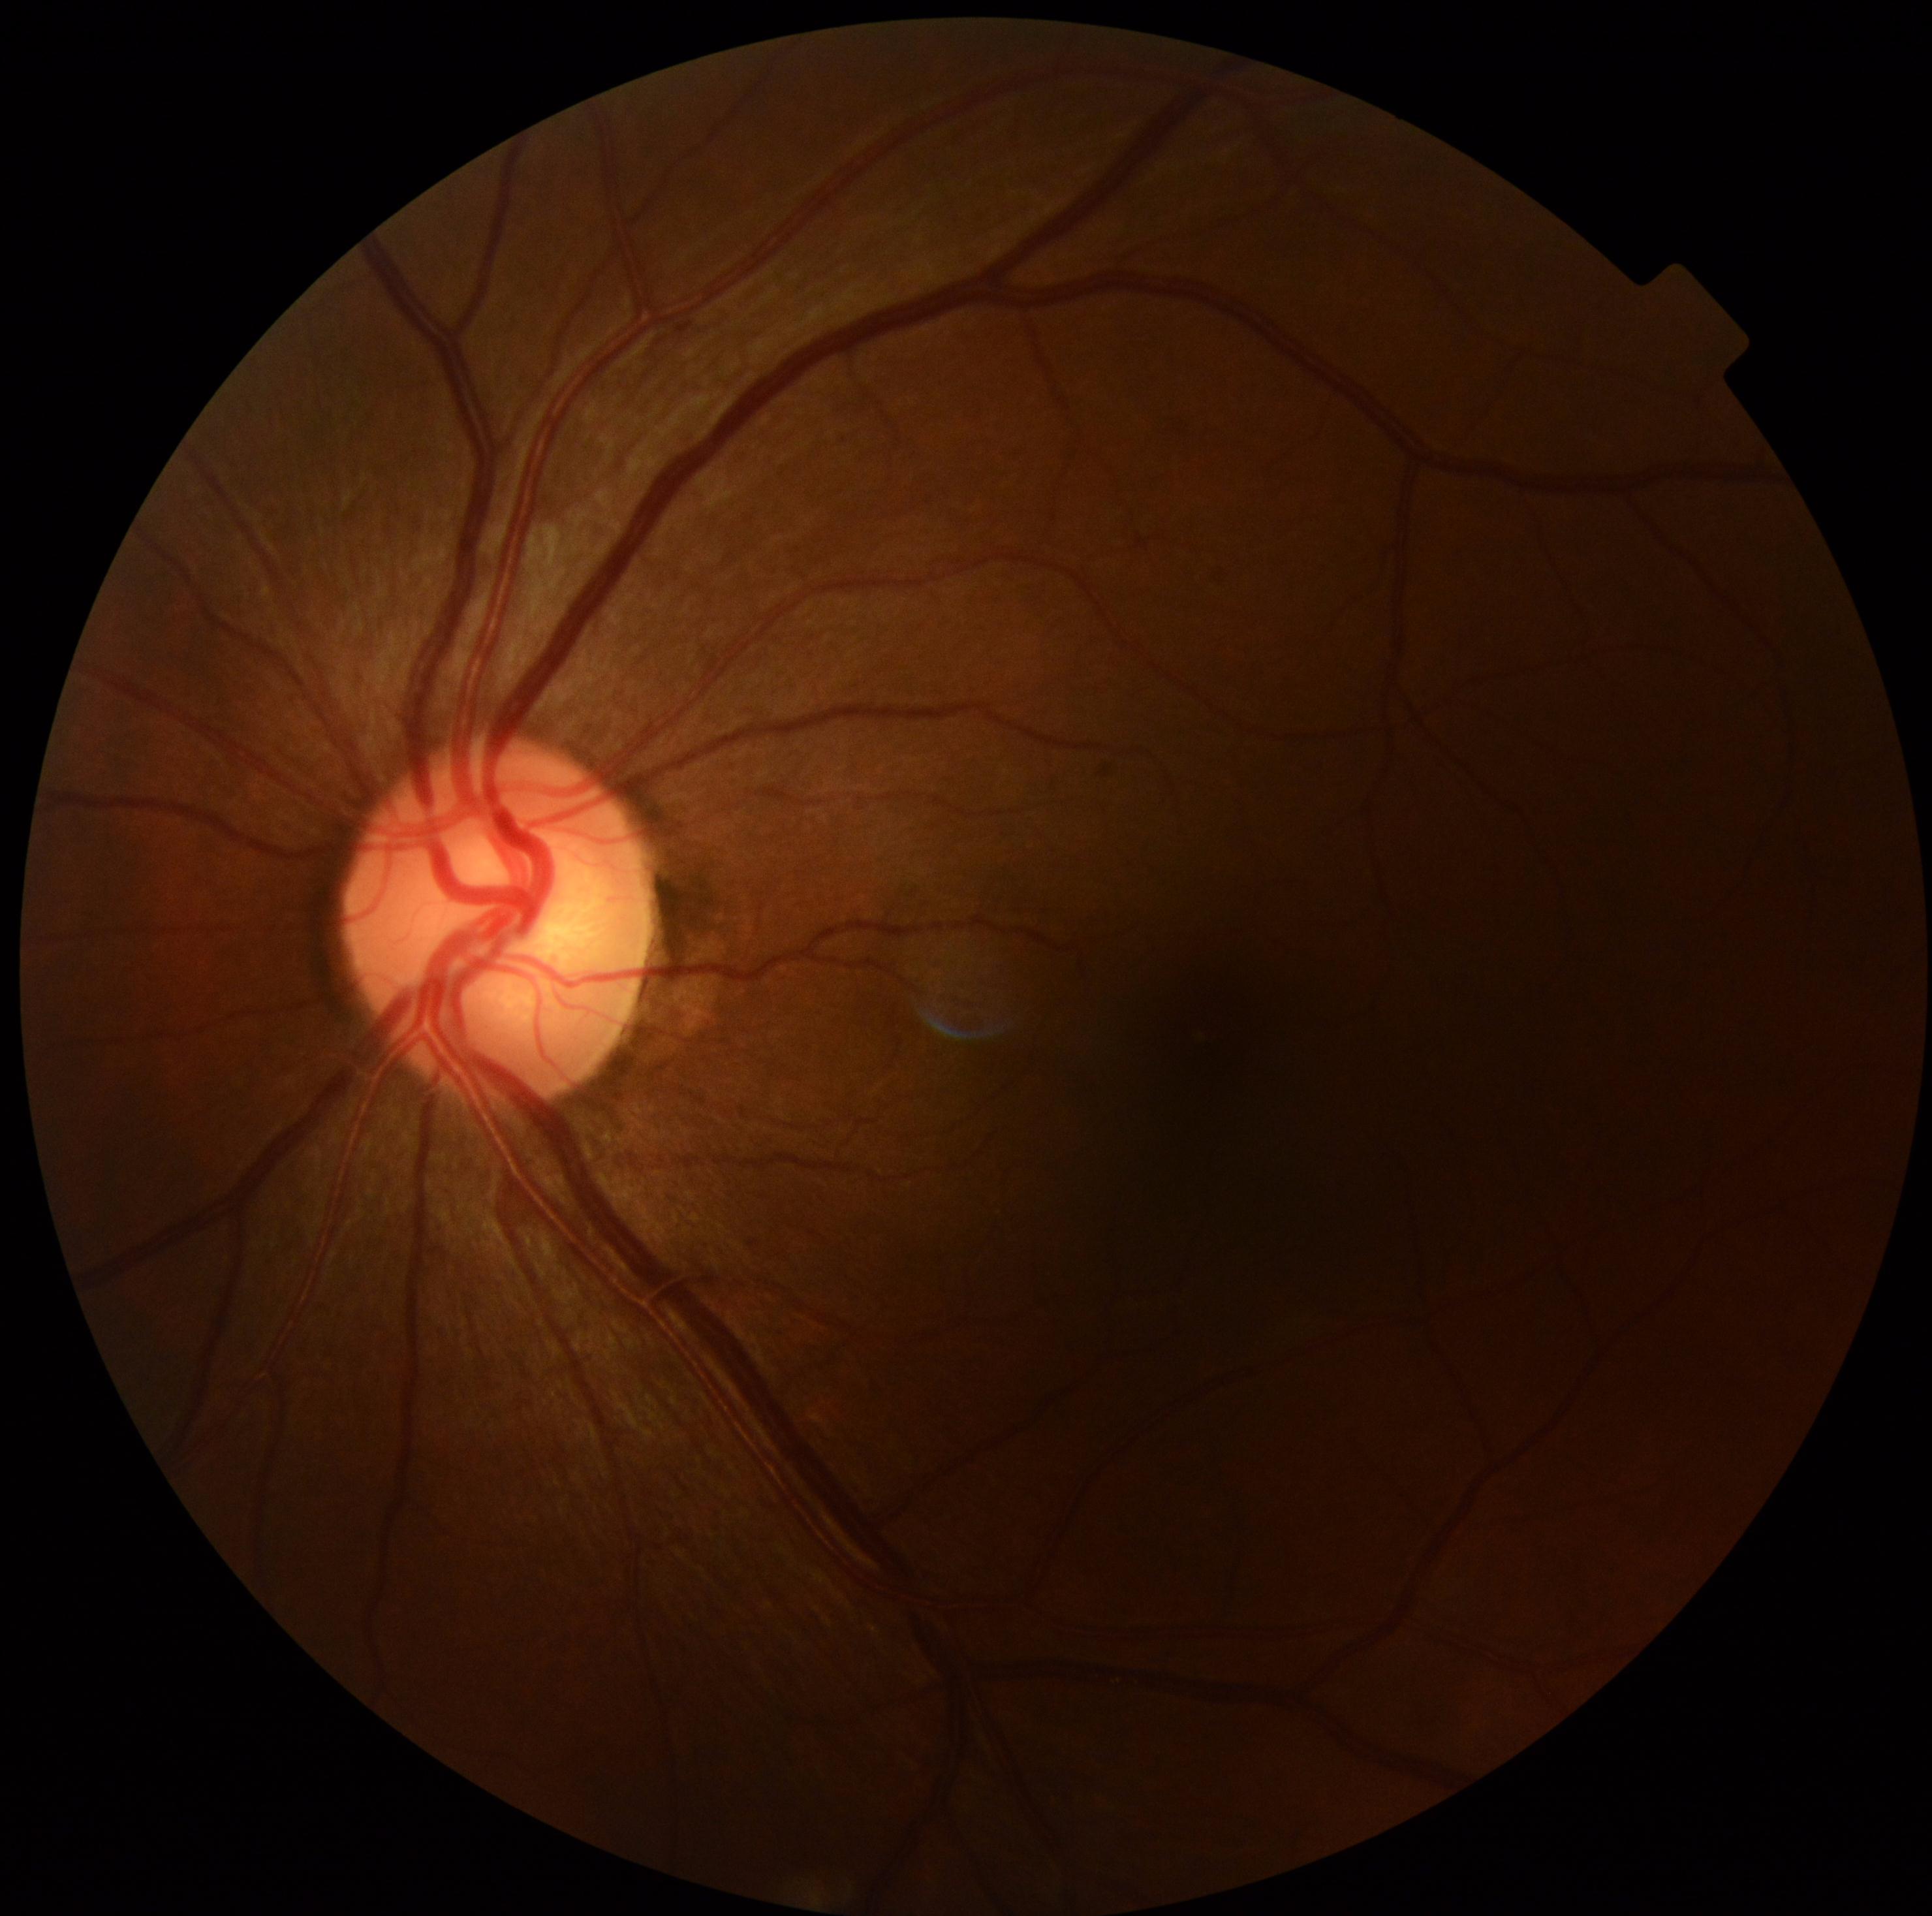 DR stage: 0.
No DR findings.